Retinal fundus photograph: 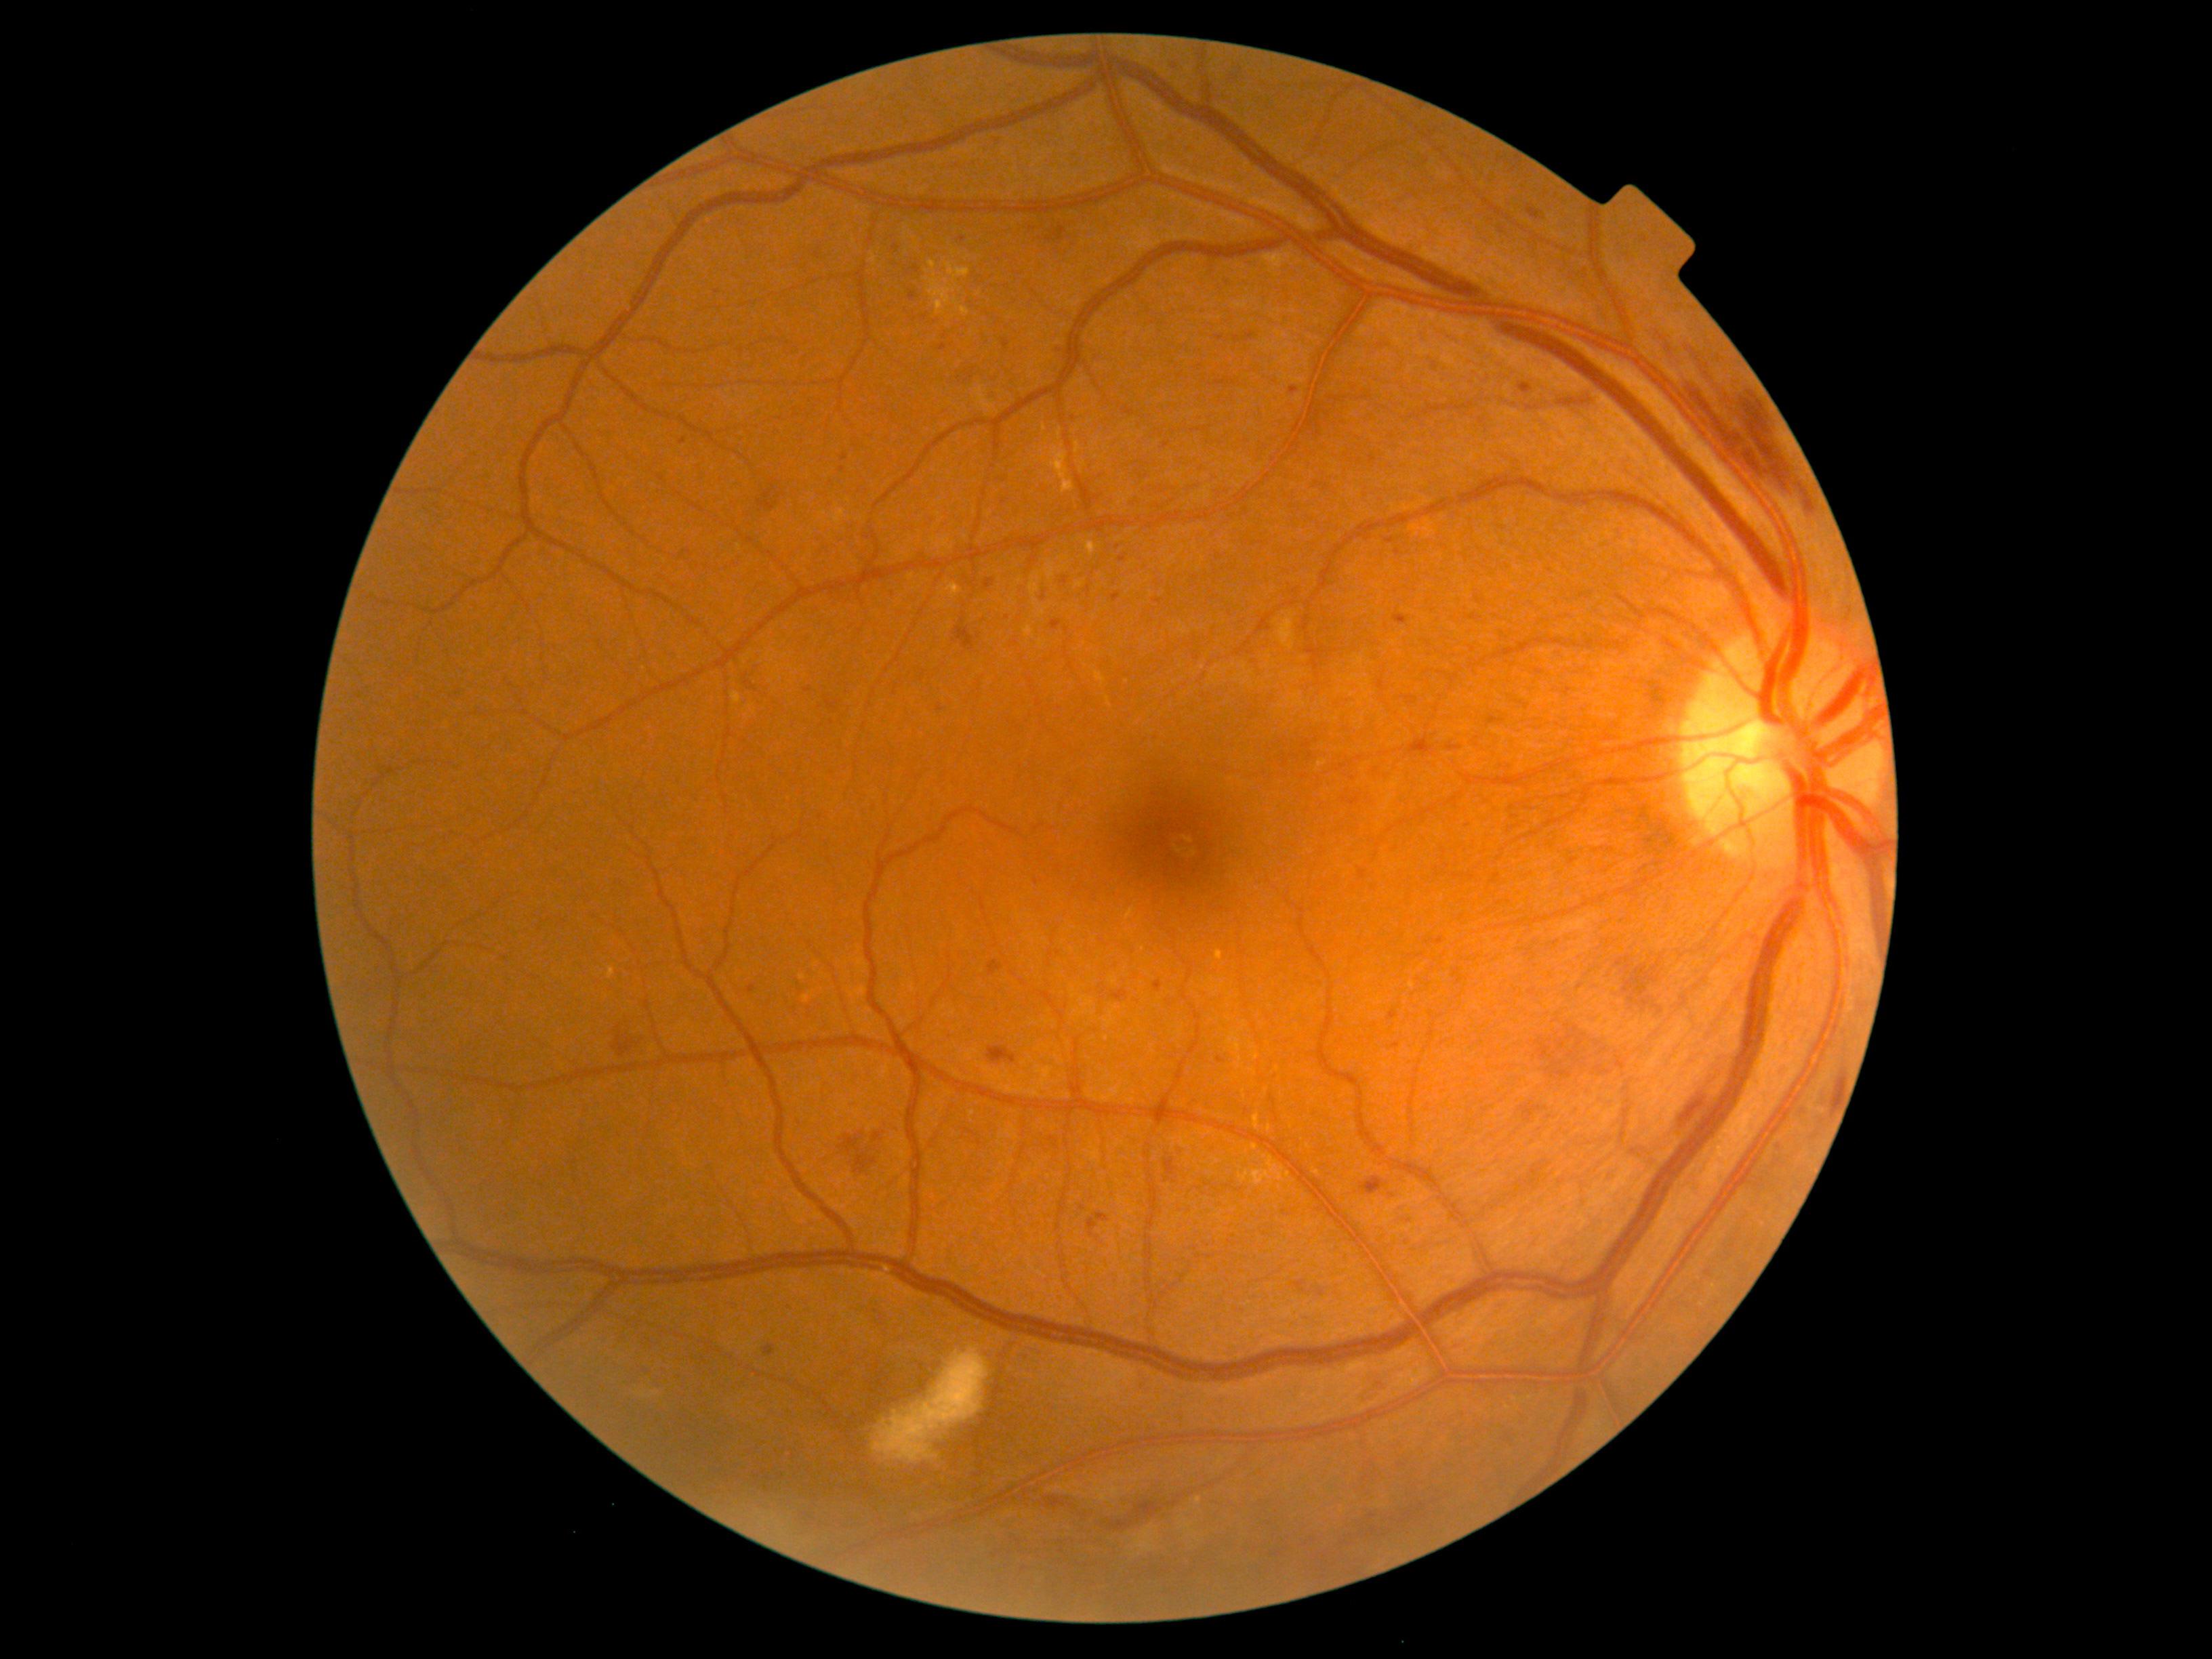 Diabetic retinopathy (DR) is grade 3 (severe NPDR).